Image size 2346x1568 — 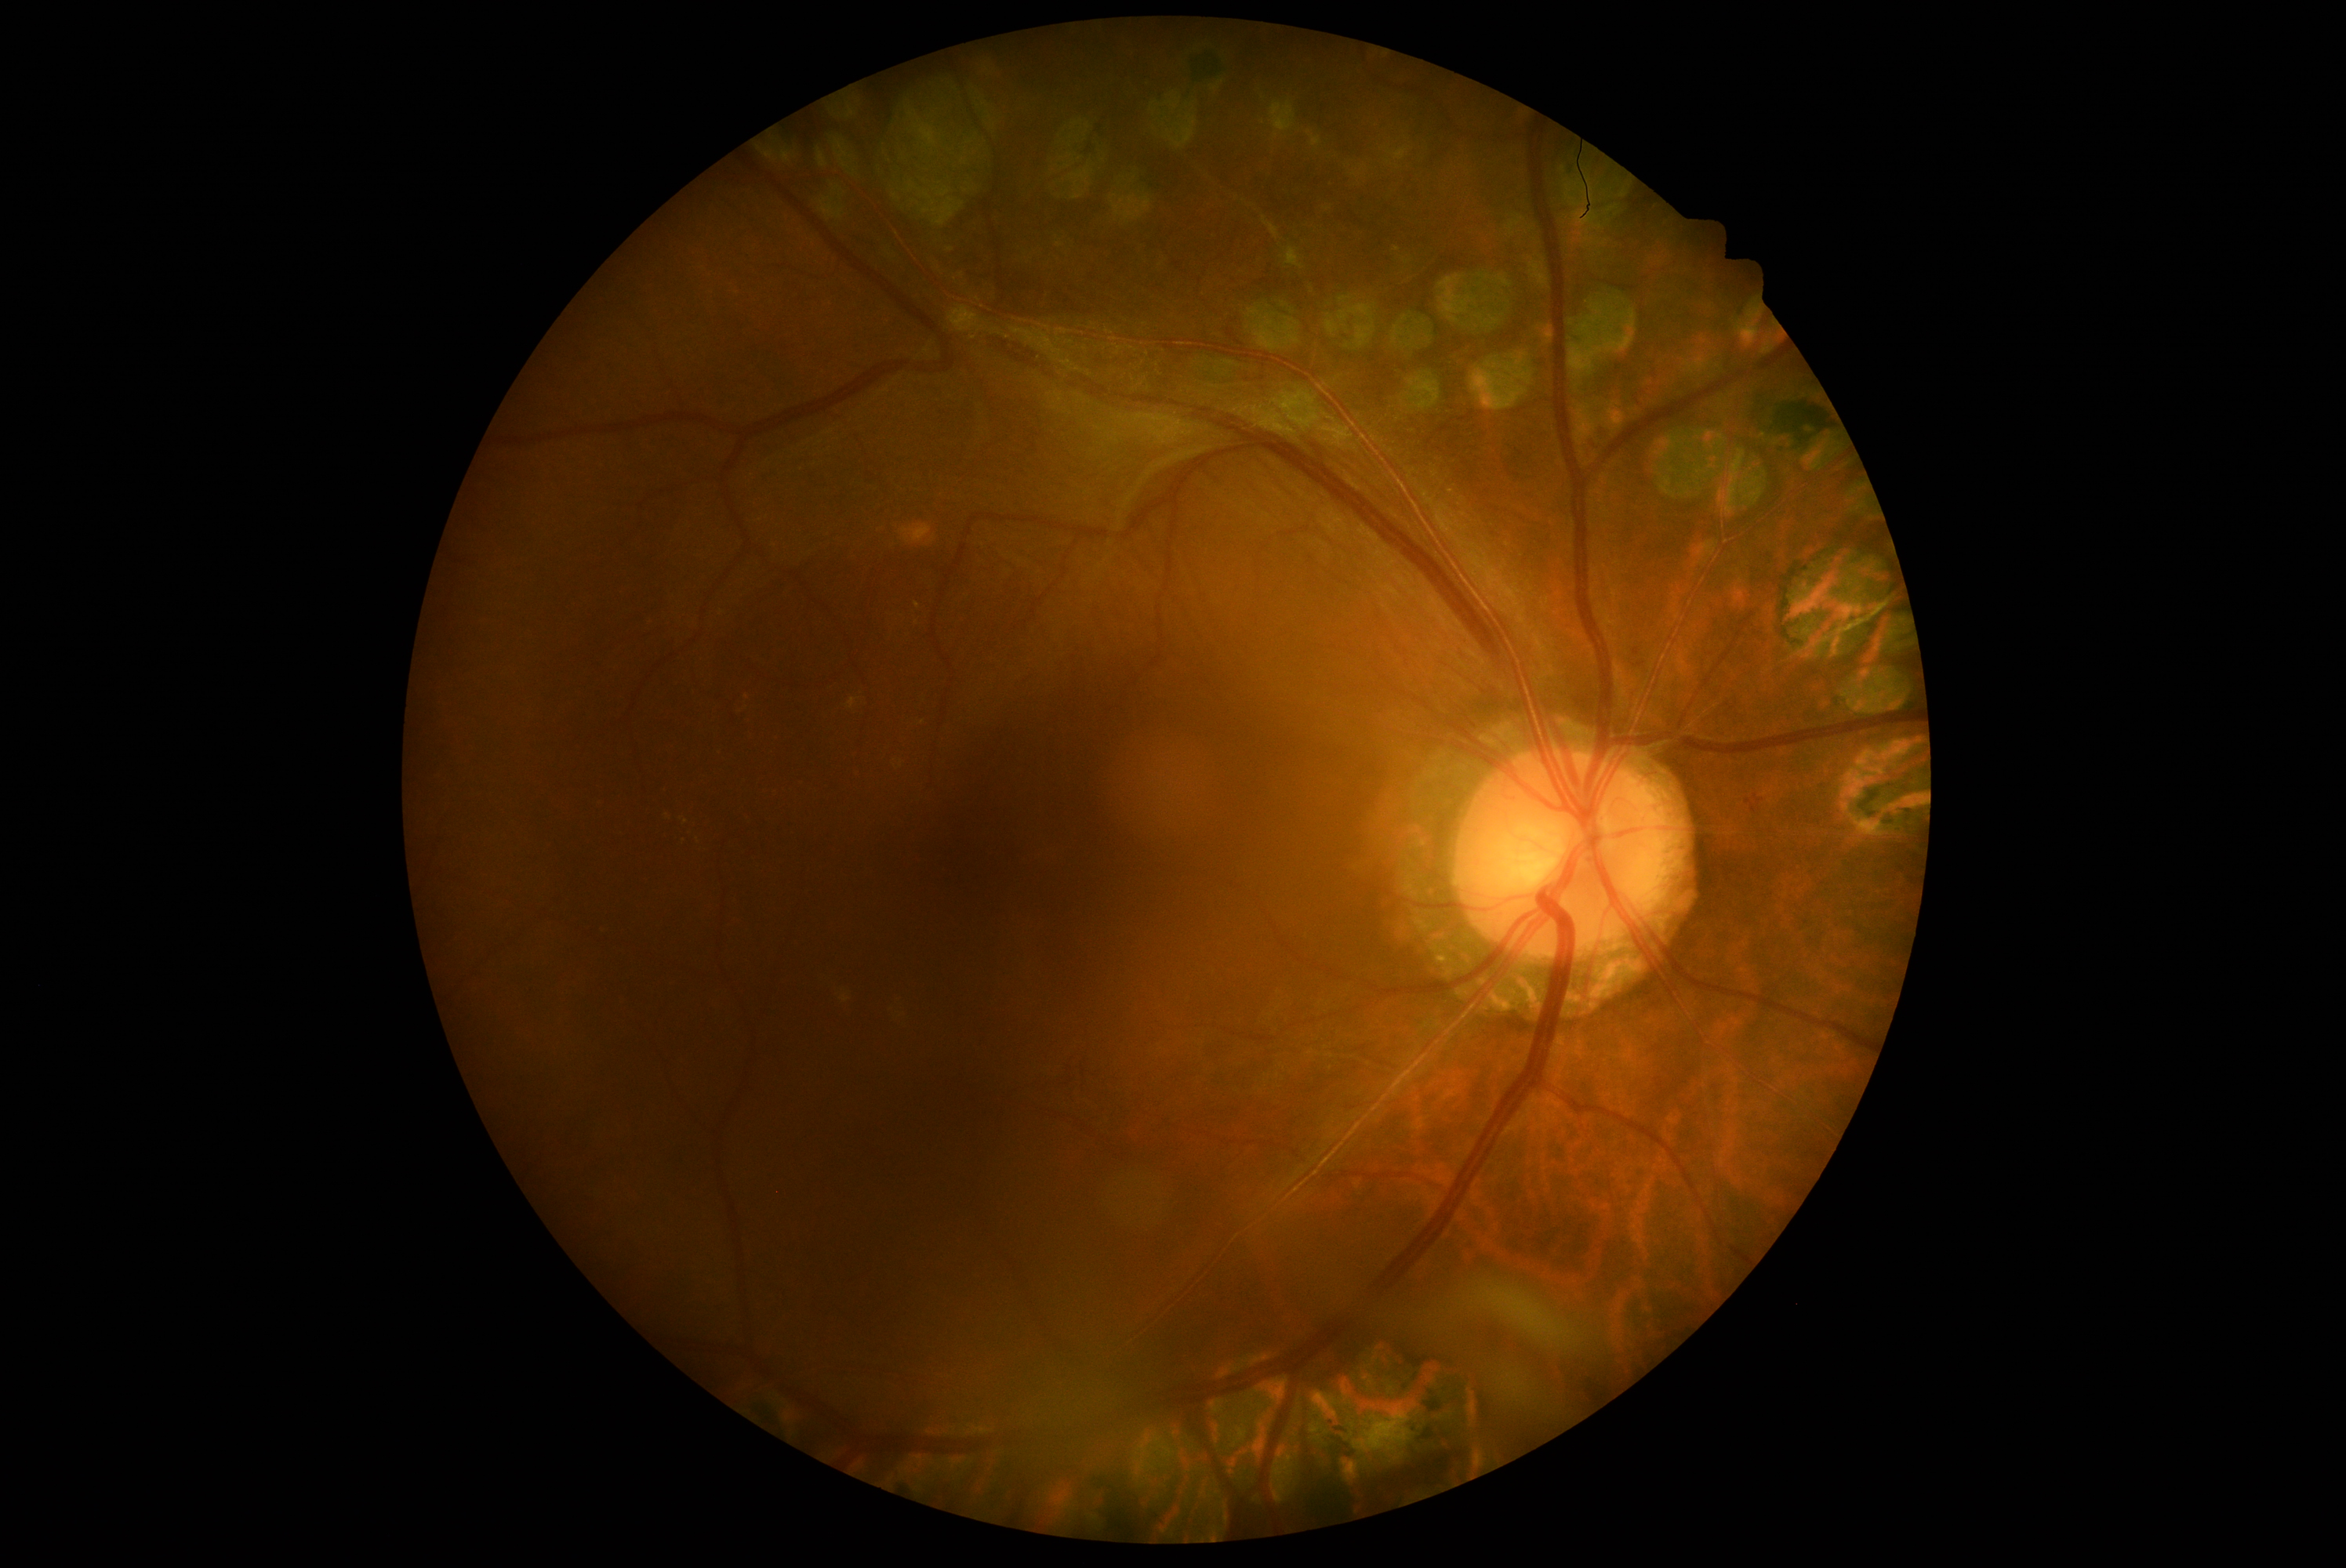
Retinopathy grade is 4 — neovascularization and/or vitreous/pre-retinal hemorrhage.